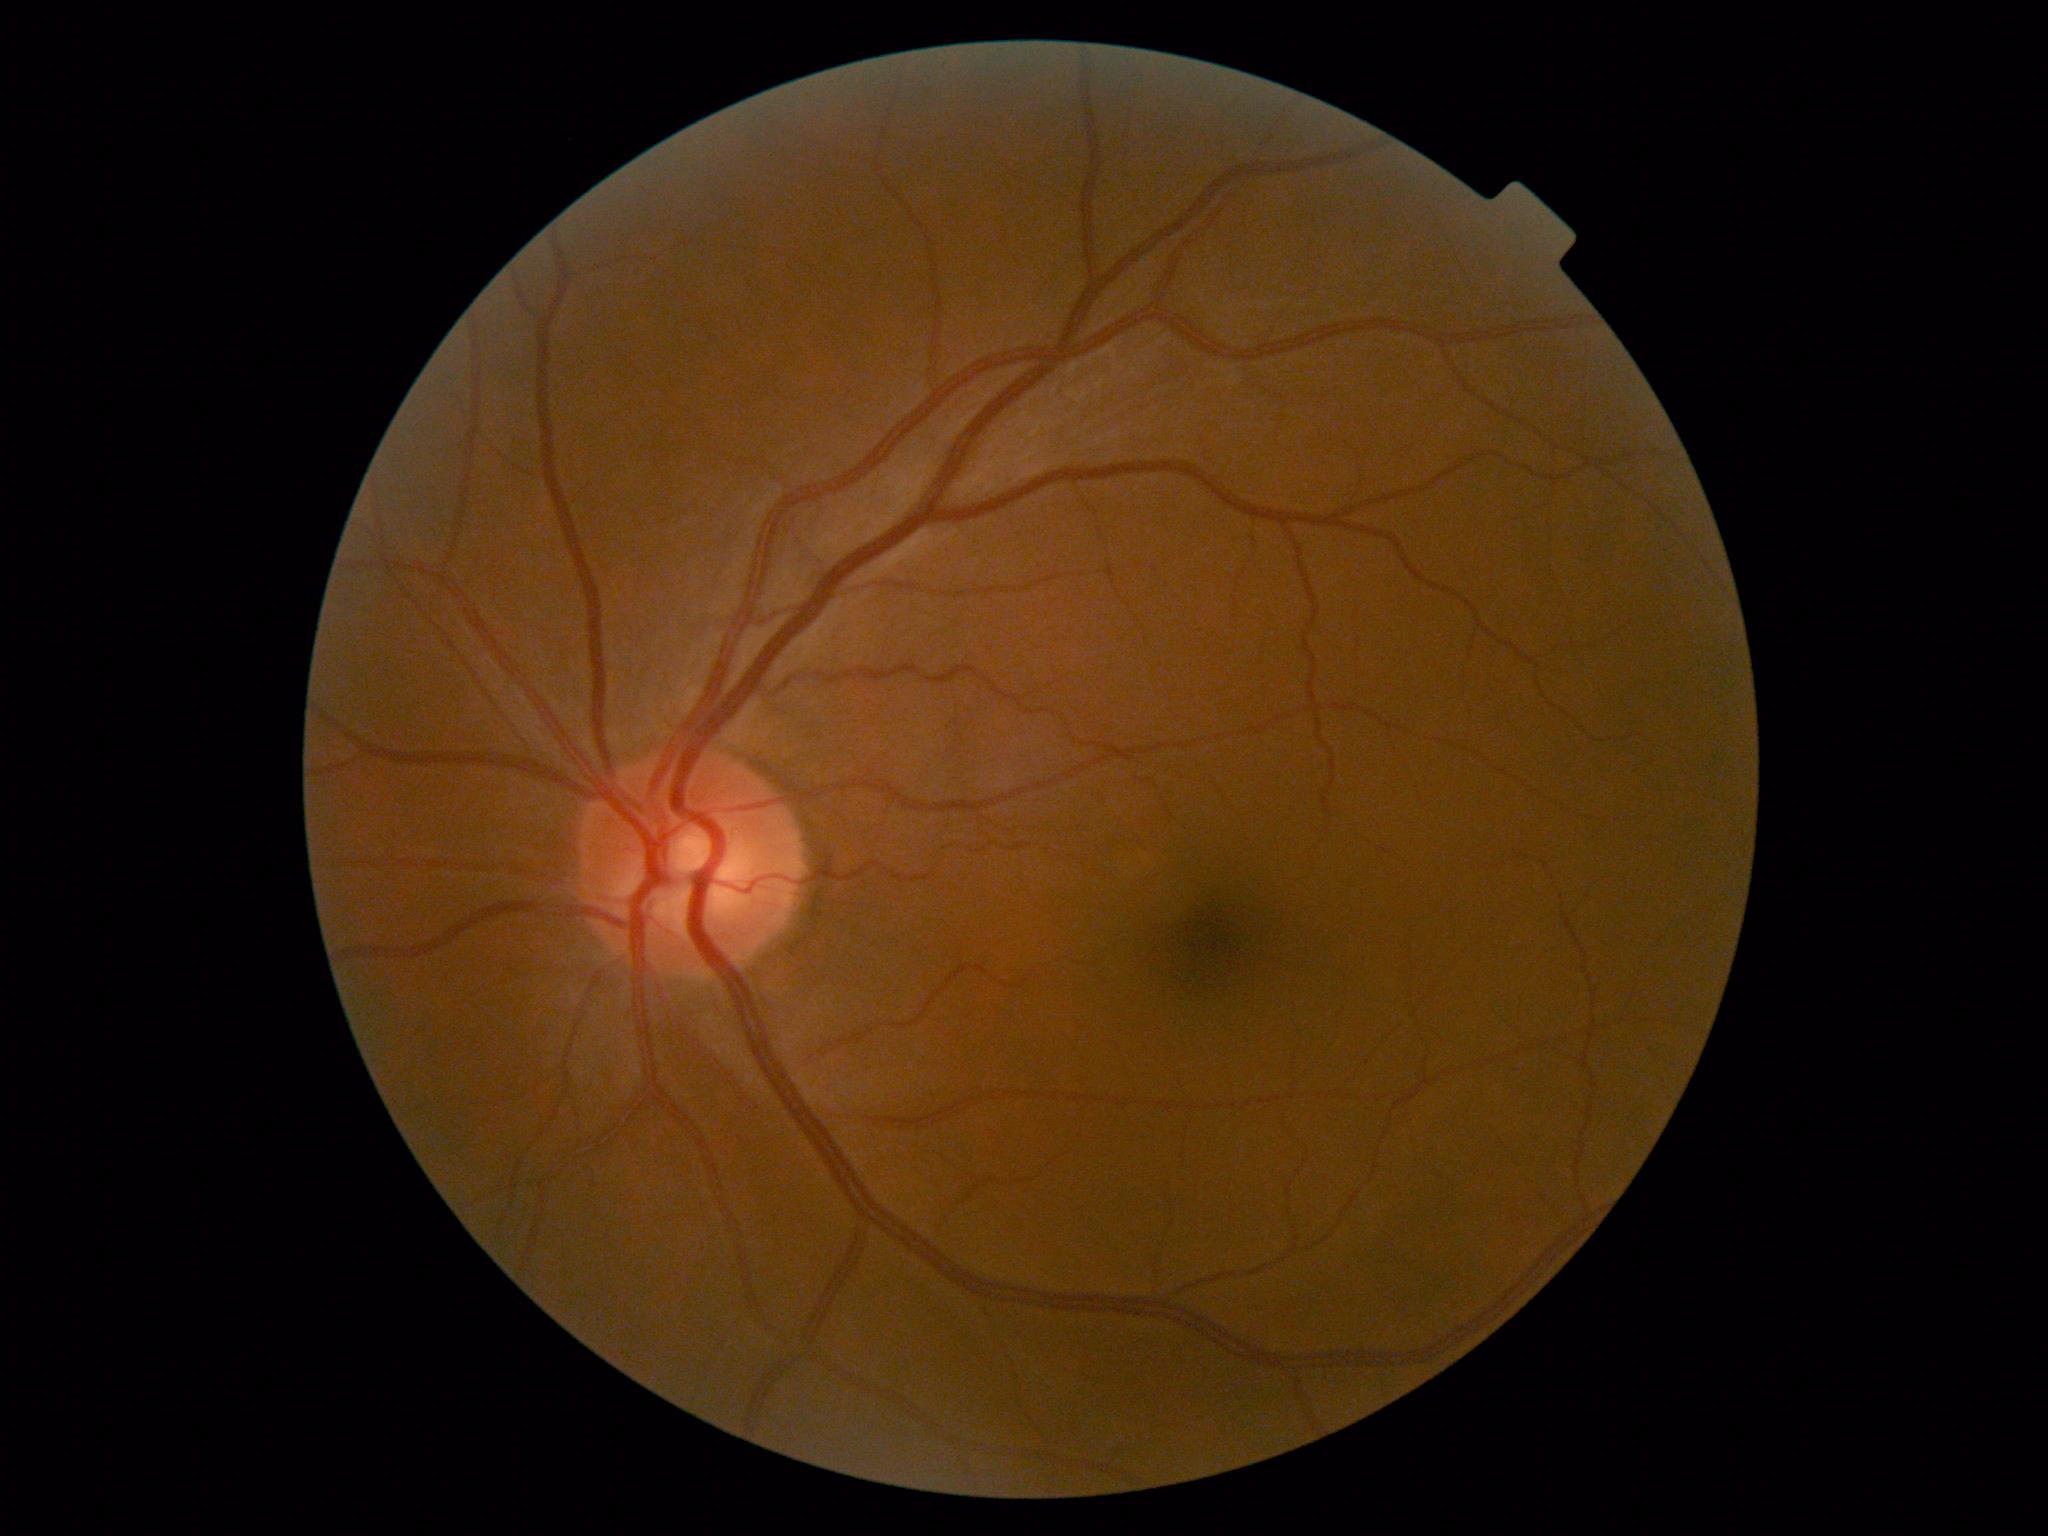

Retinopathy: grade 0. No apparent diabetic retinopathy.